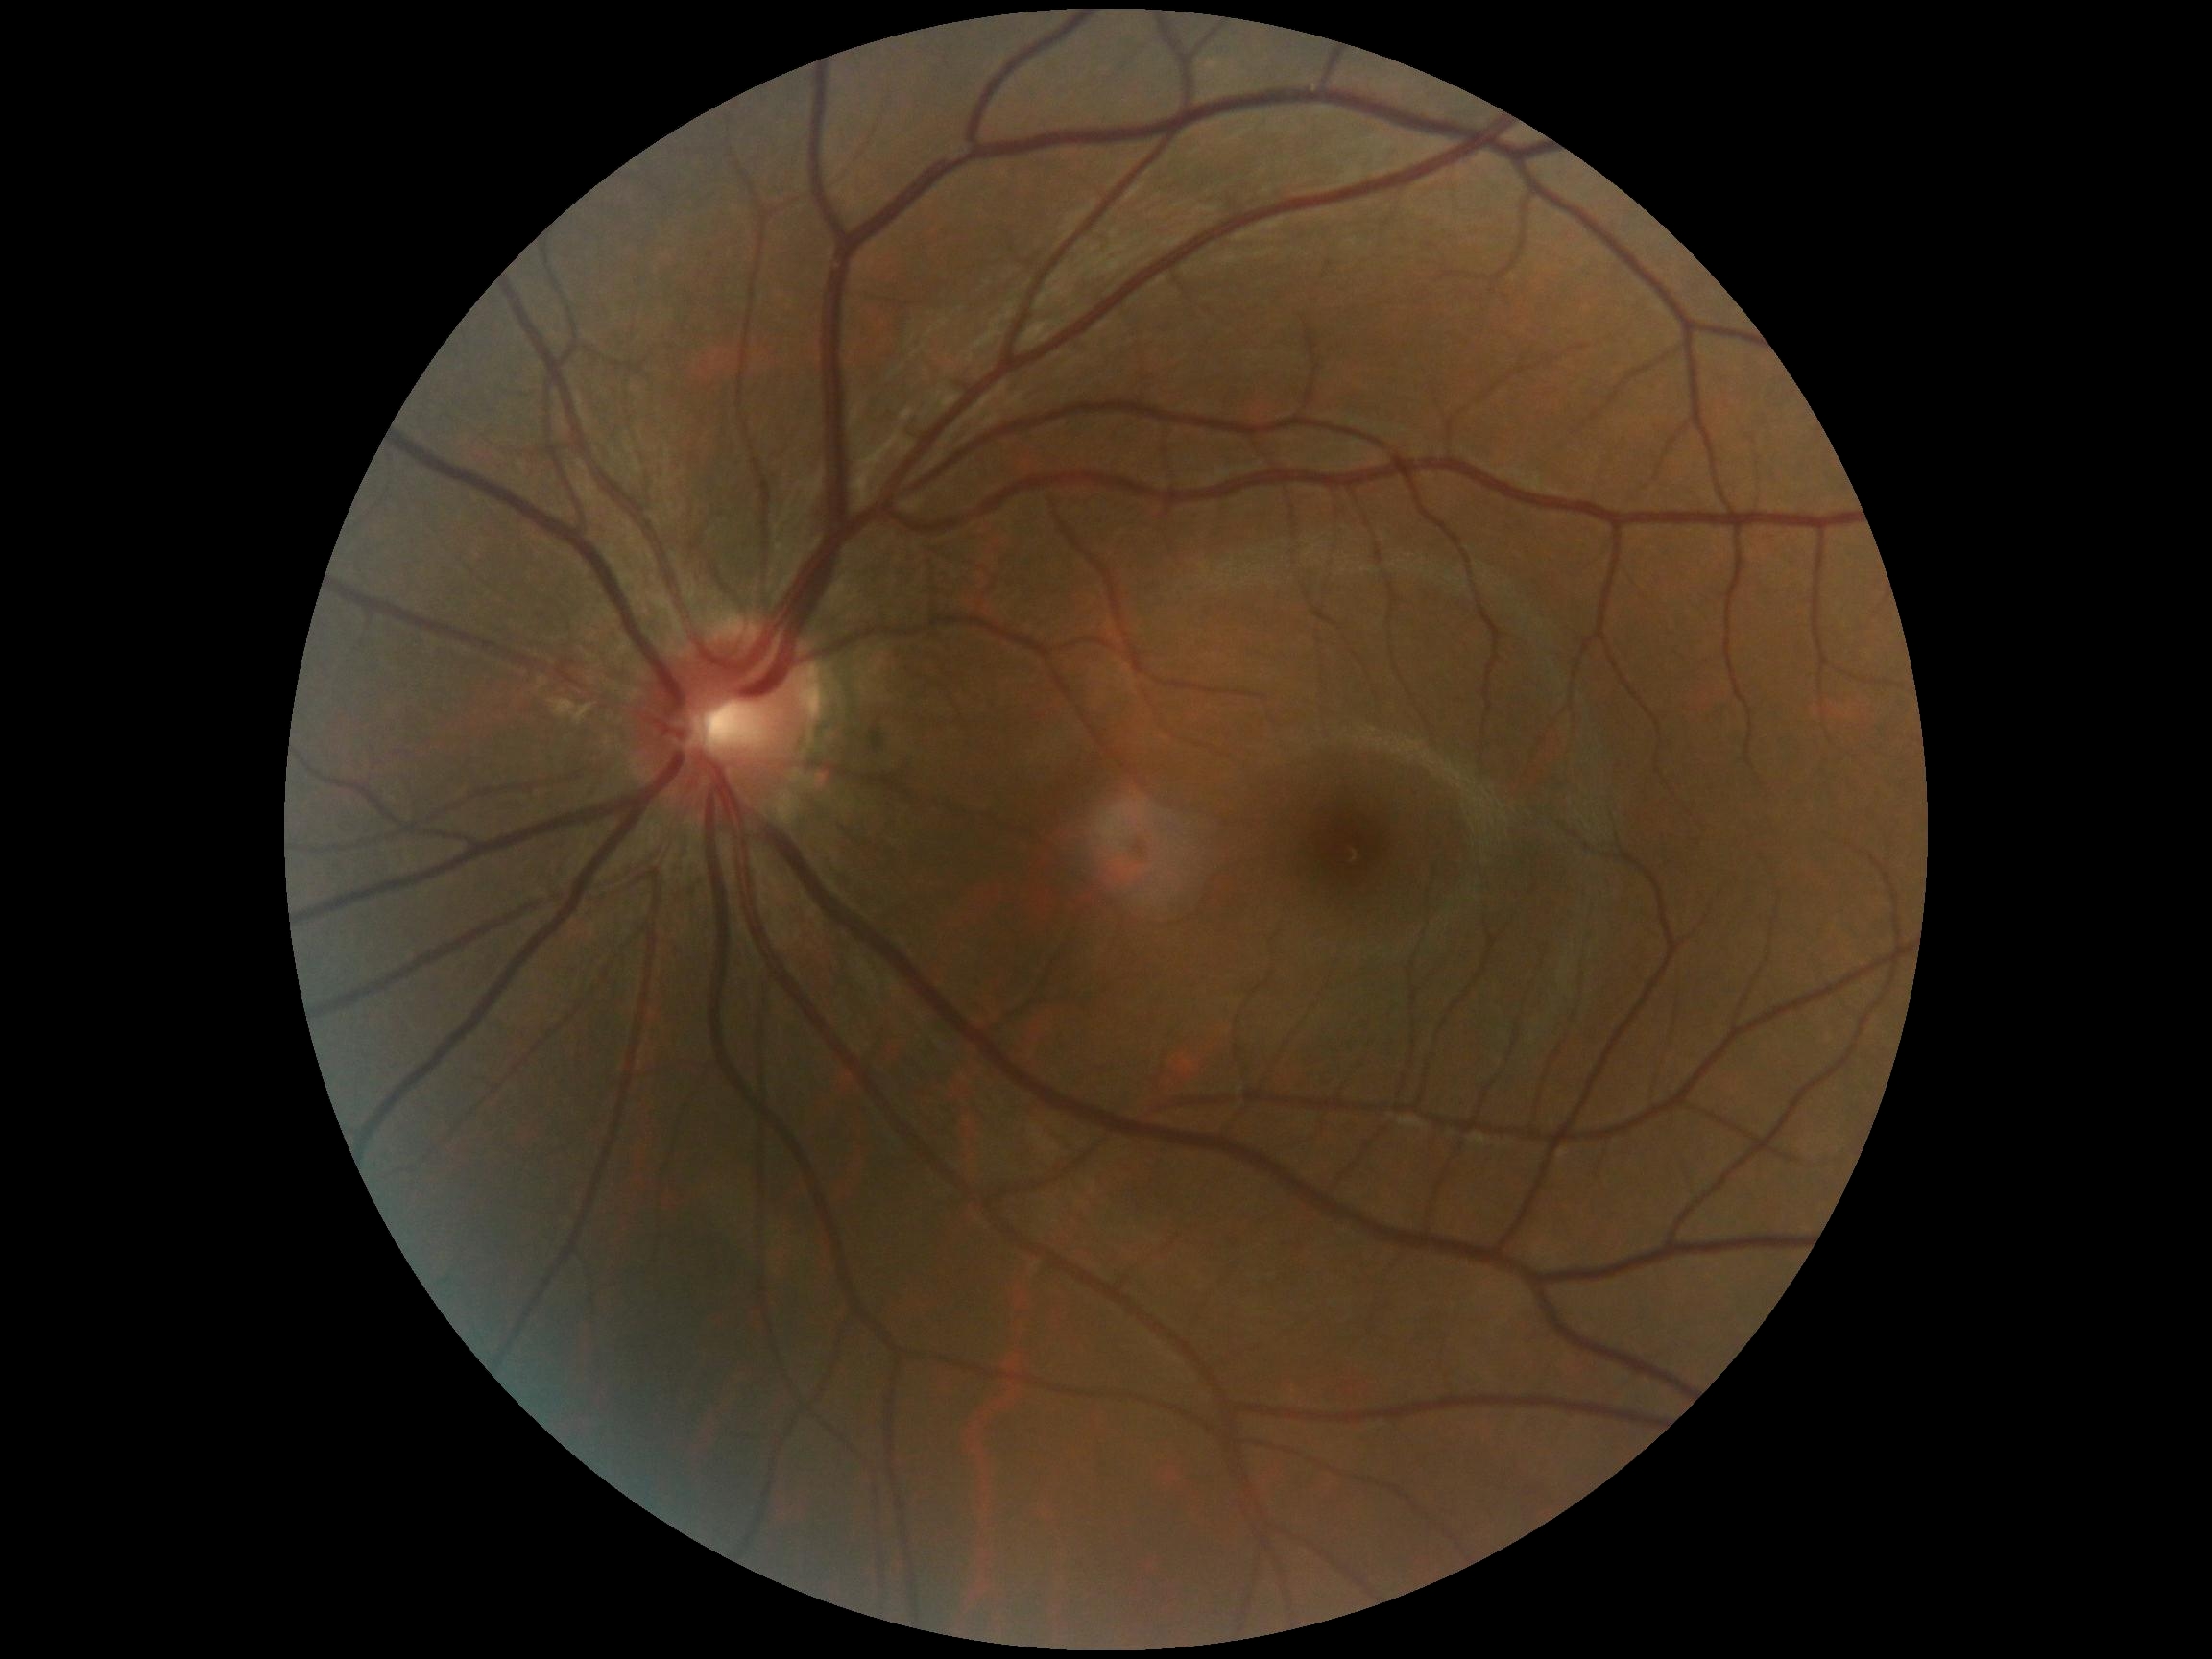 No signs of diabetic retinopathy. Retinopathy is 0/4.